CFP, 2228x1652.
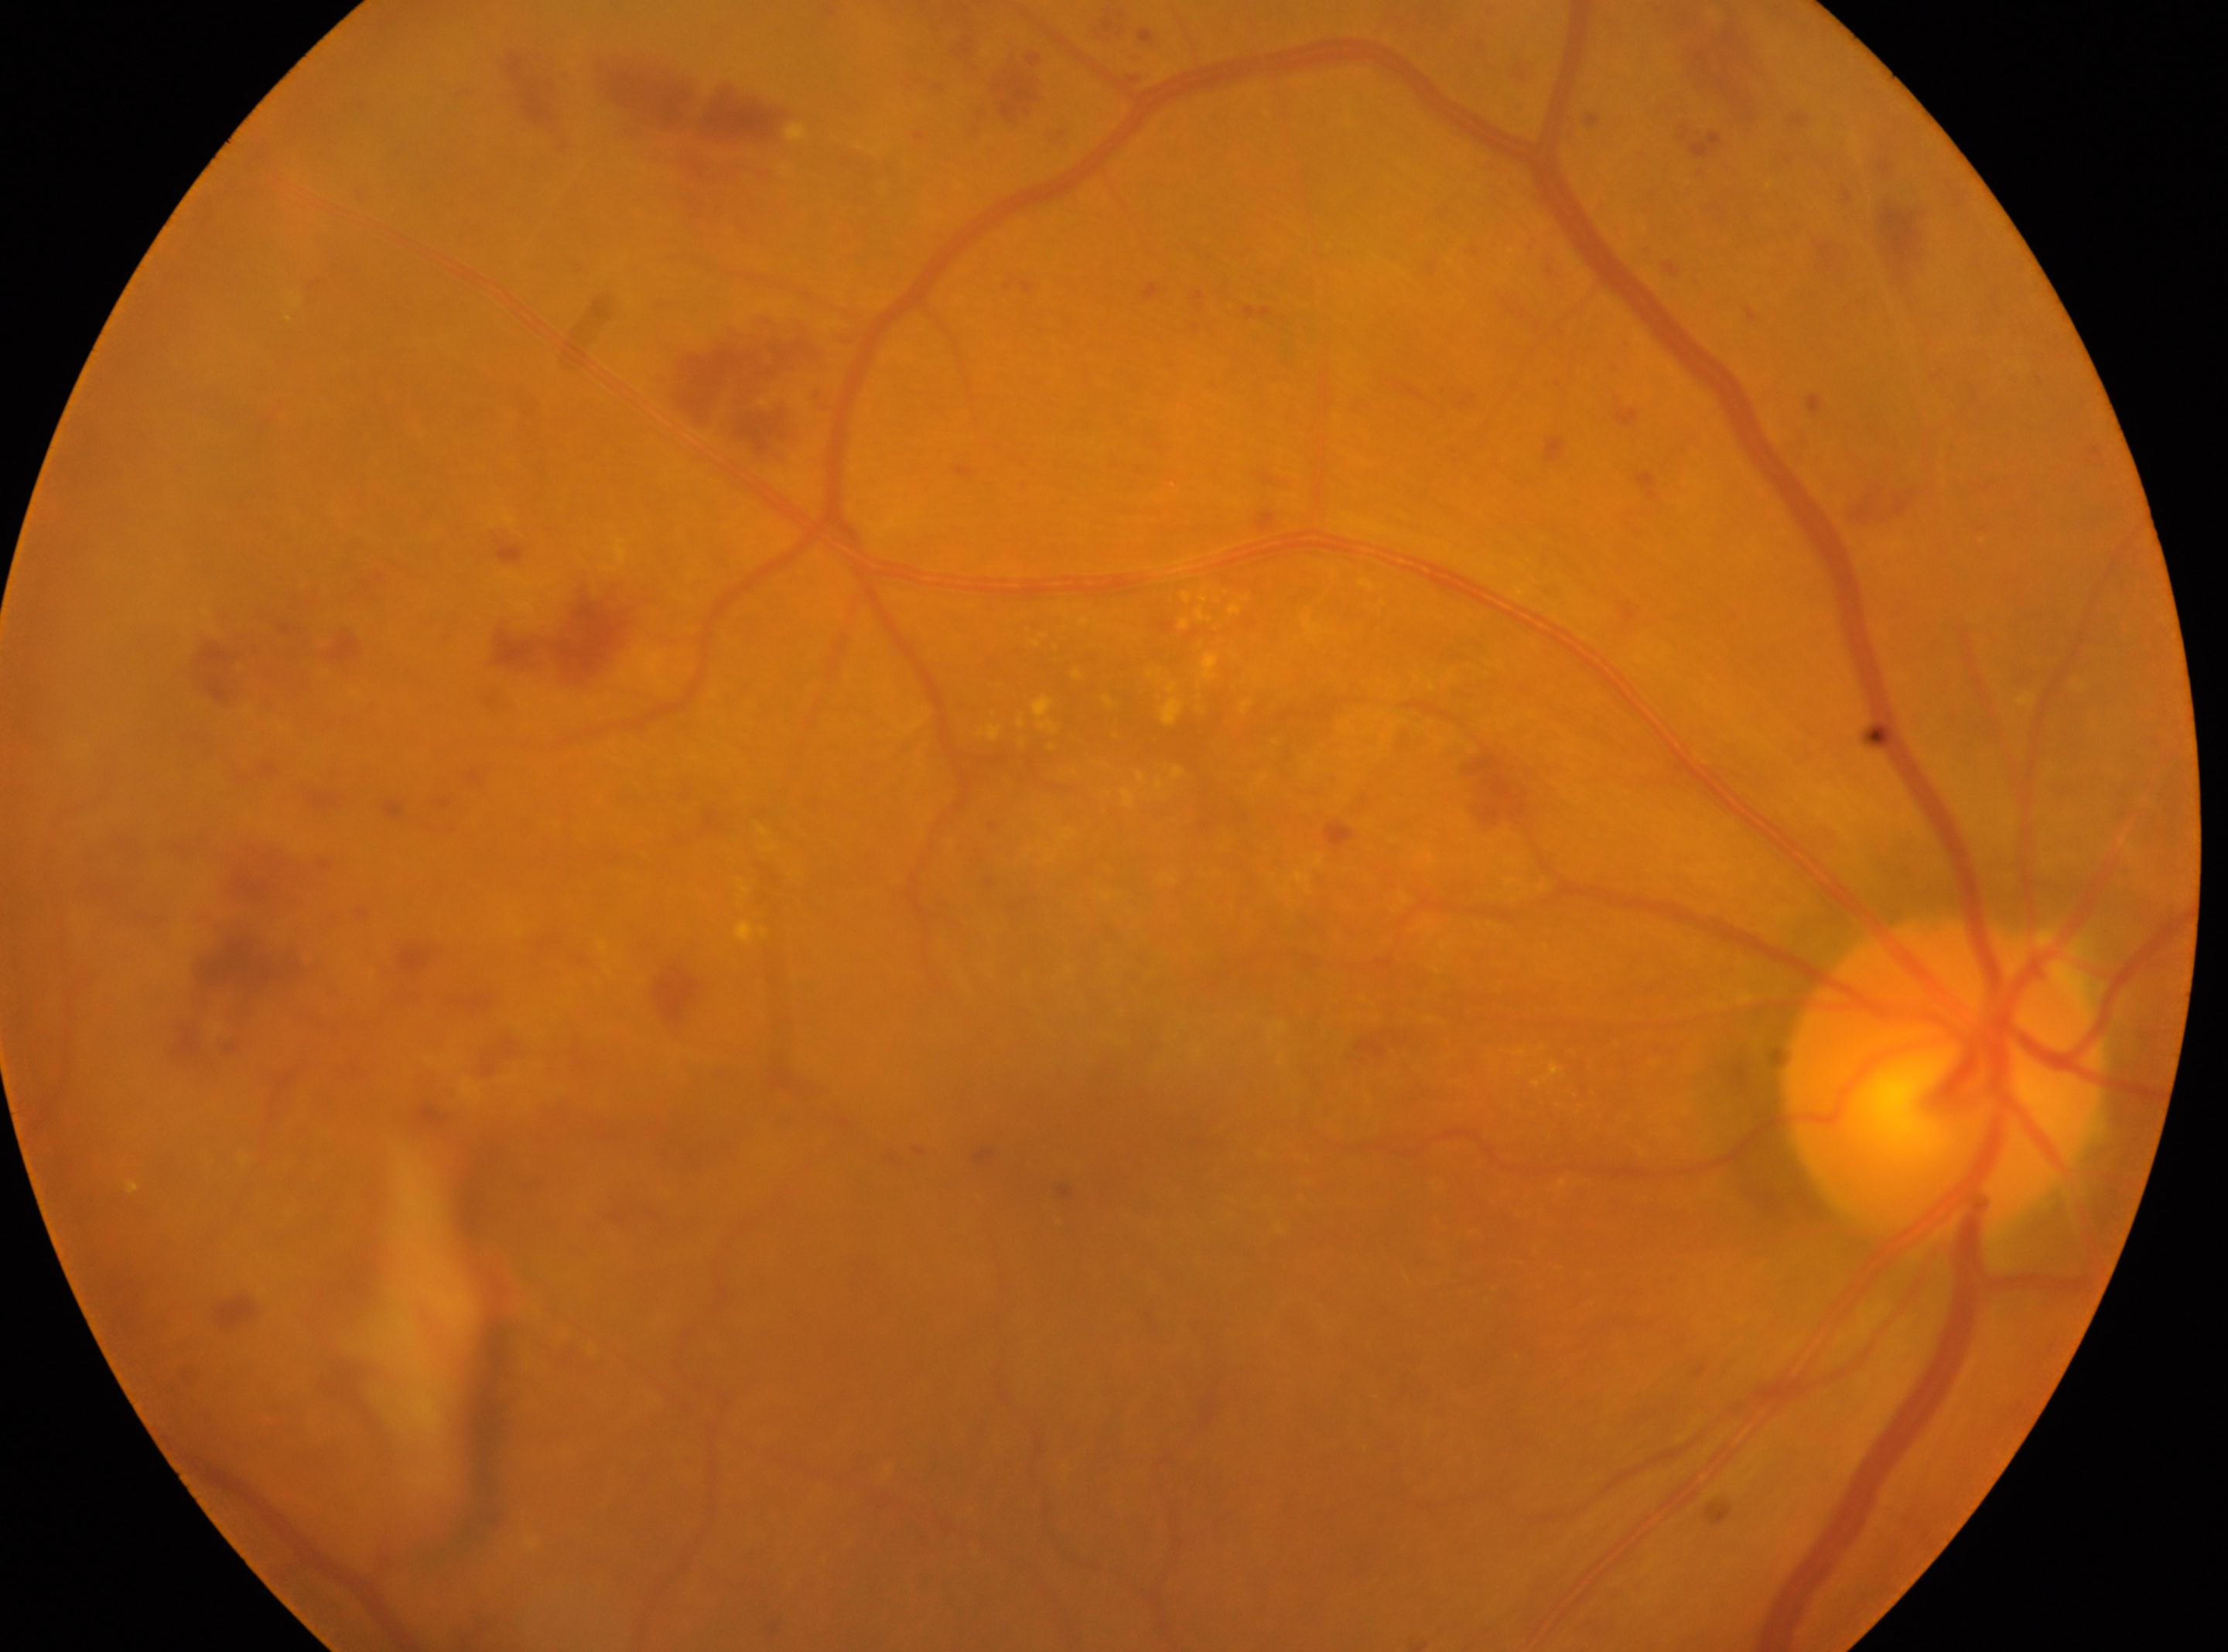

{
  "dr_grade": "2/4",
  "eye": "right eye",
  "optic_disc": "[1943, 1078]",
  "fovea": "[1109, 1134]"
}